Fundus photo. 2352x1568
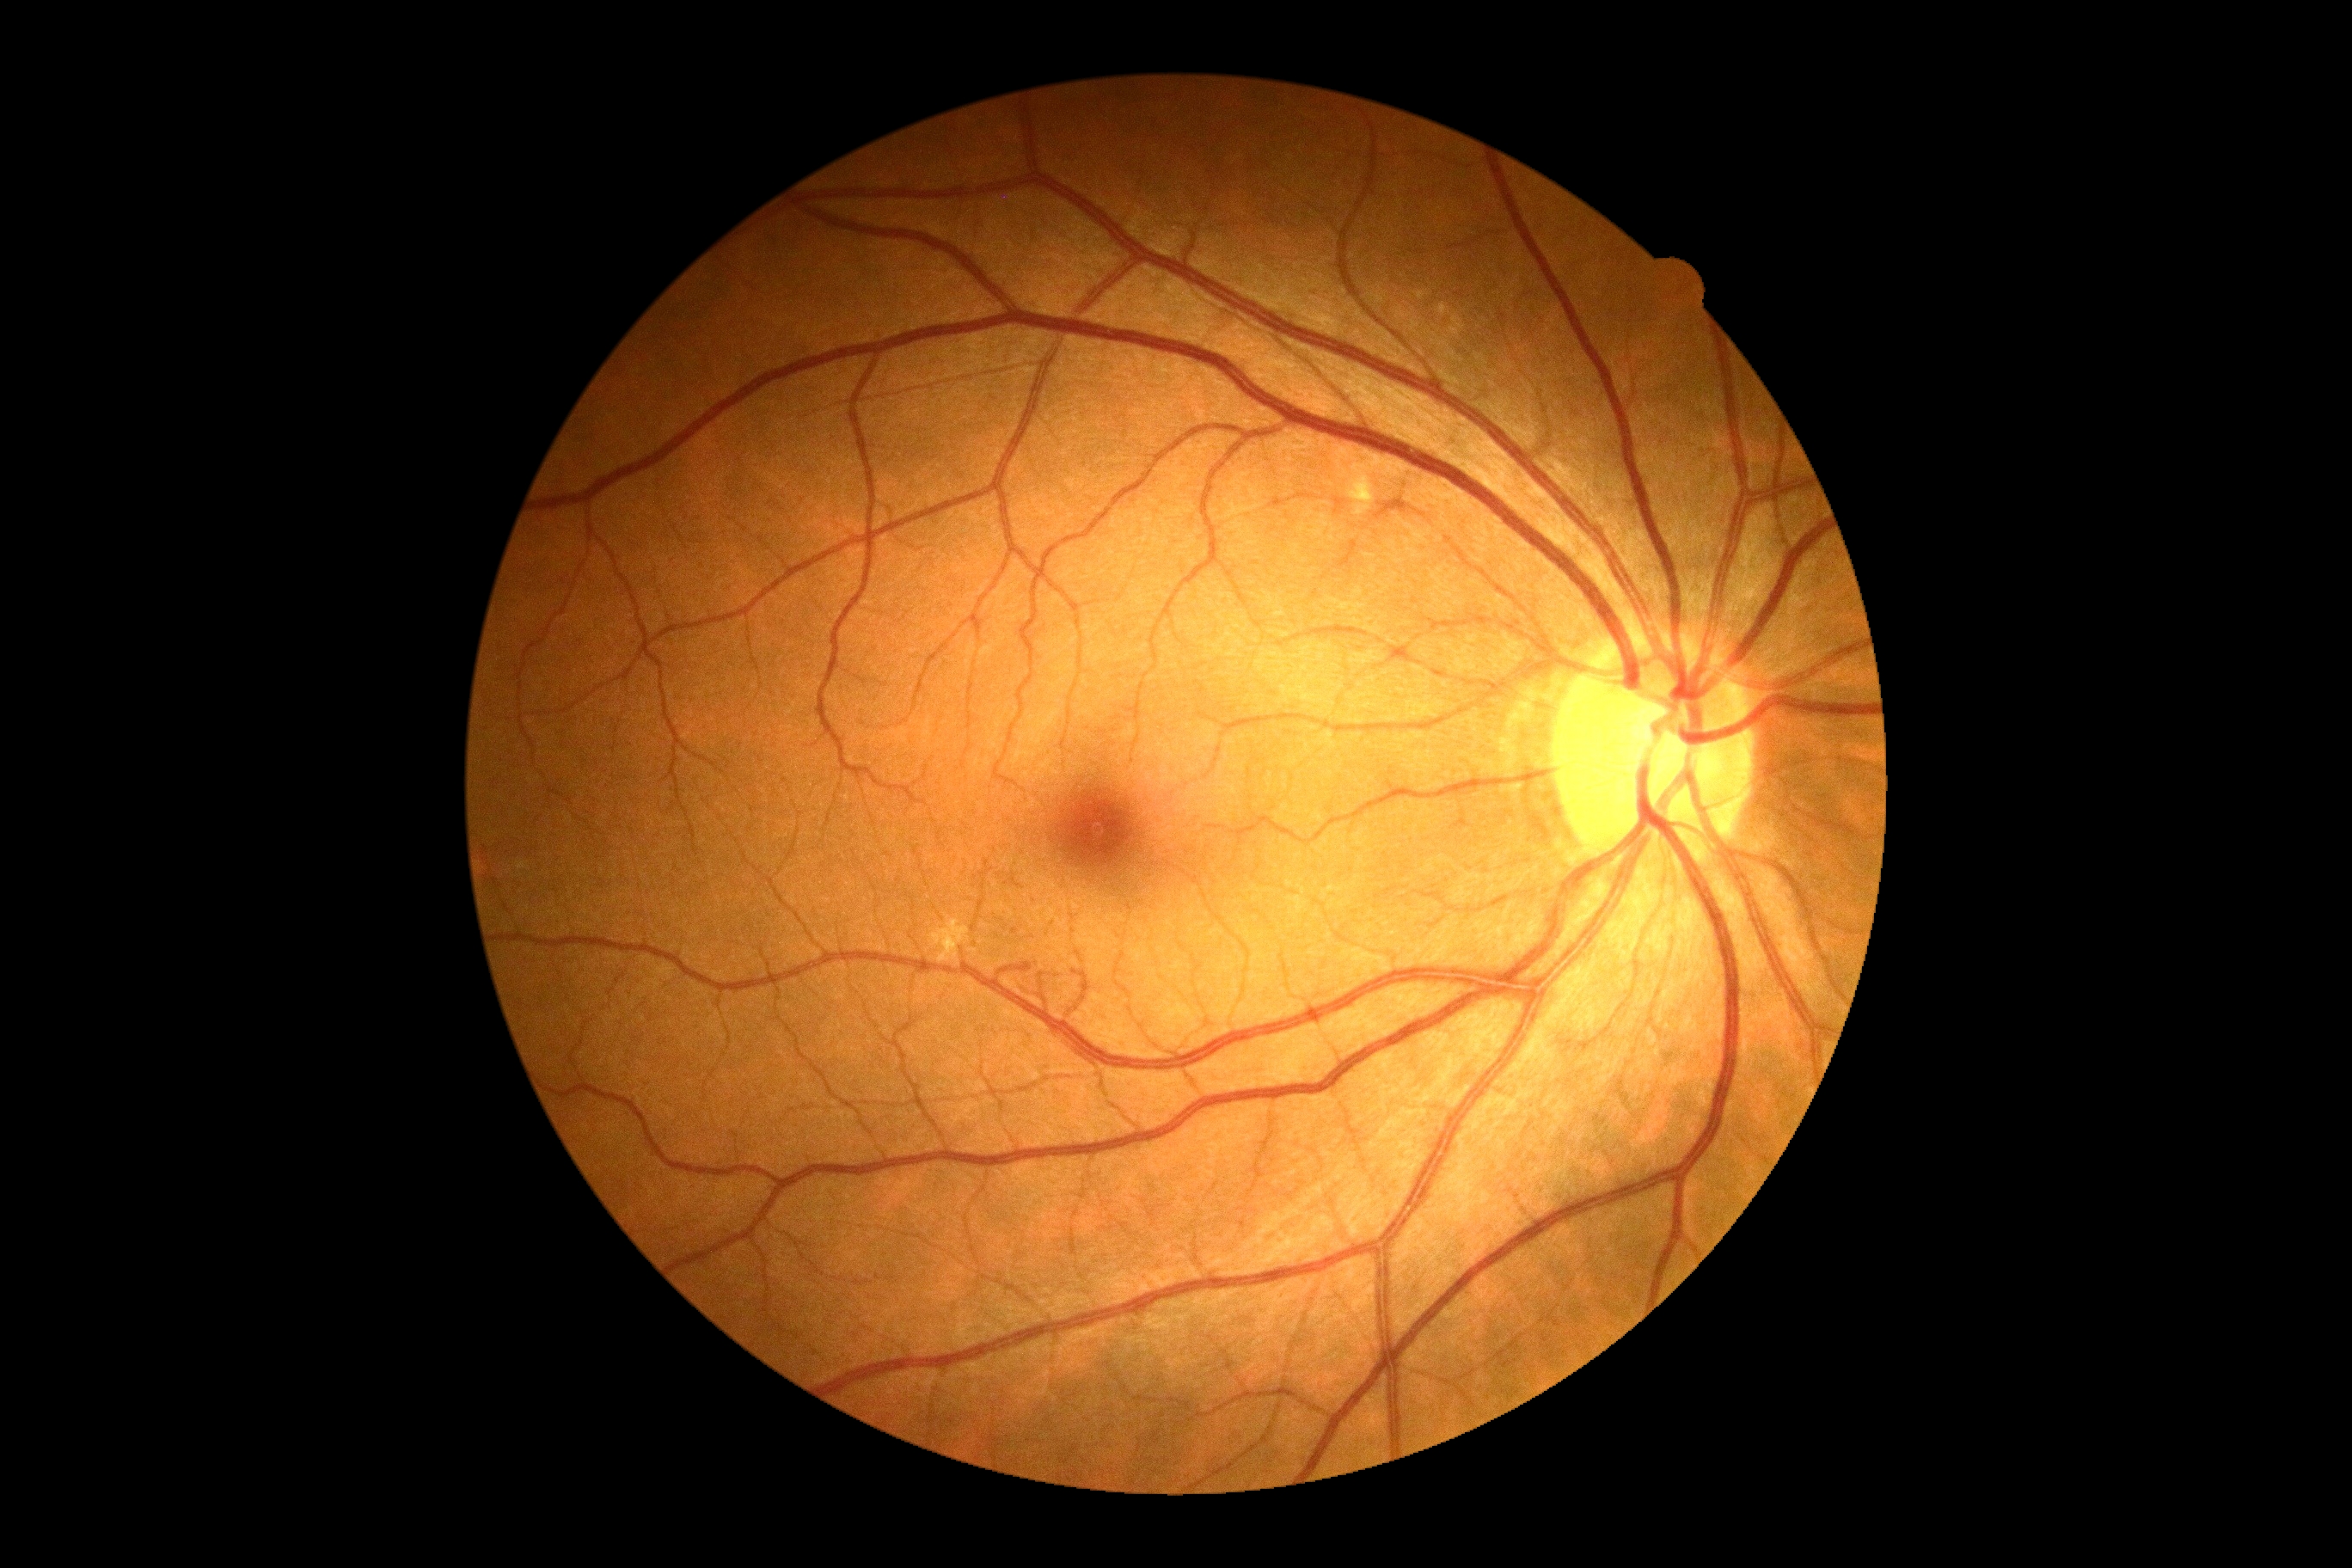
Diabetic retinopathy is moderate non-proliferative diabetic retinopathy (grade 2).
No hemorrhages identified.
Hard exudates are located at <region>929, 914, 971, 965</region>; <region>1361, 493, 1368, 506</region>.
No soft exudates identified.
No microaneurysms identified.